240 by 240 pixels
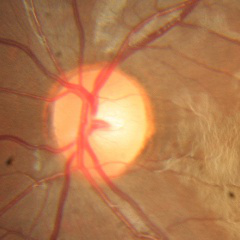

Fundus appearance consistent with no glaucoma.